50-degree field of view. Camera: Topcon TRC-50DX. Central posterior field. Captured after pupil dilation. Image size 2228x1652. Retinal fundus photograph: 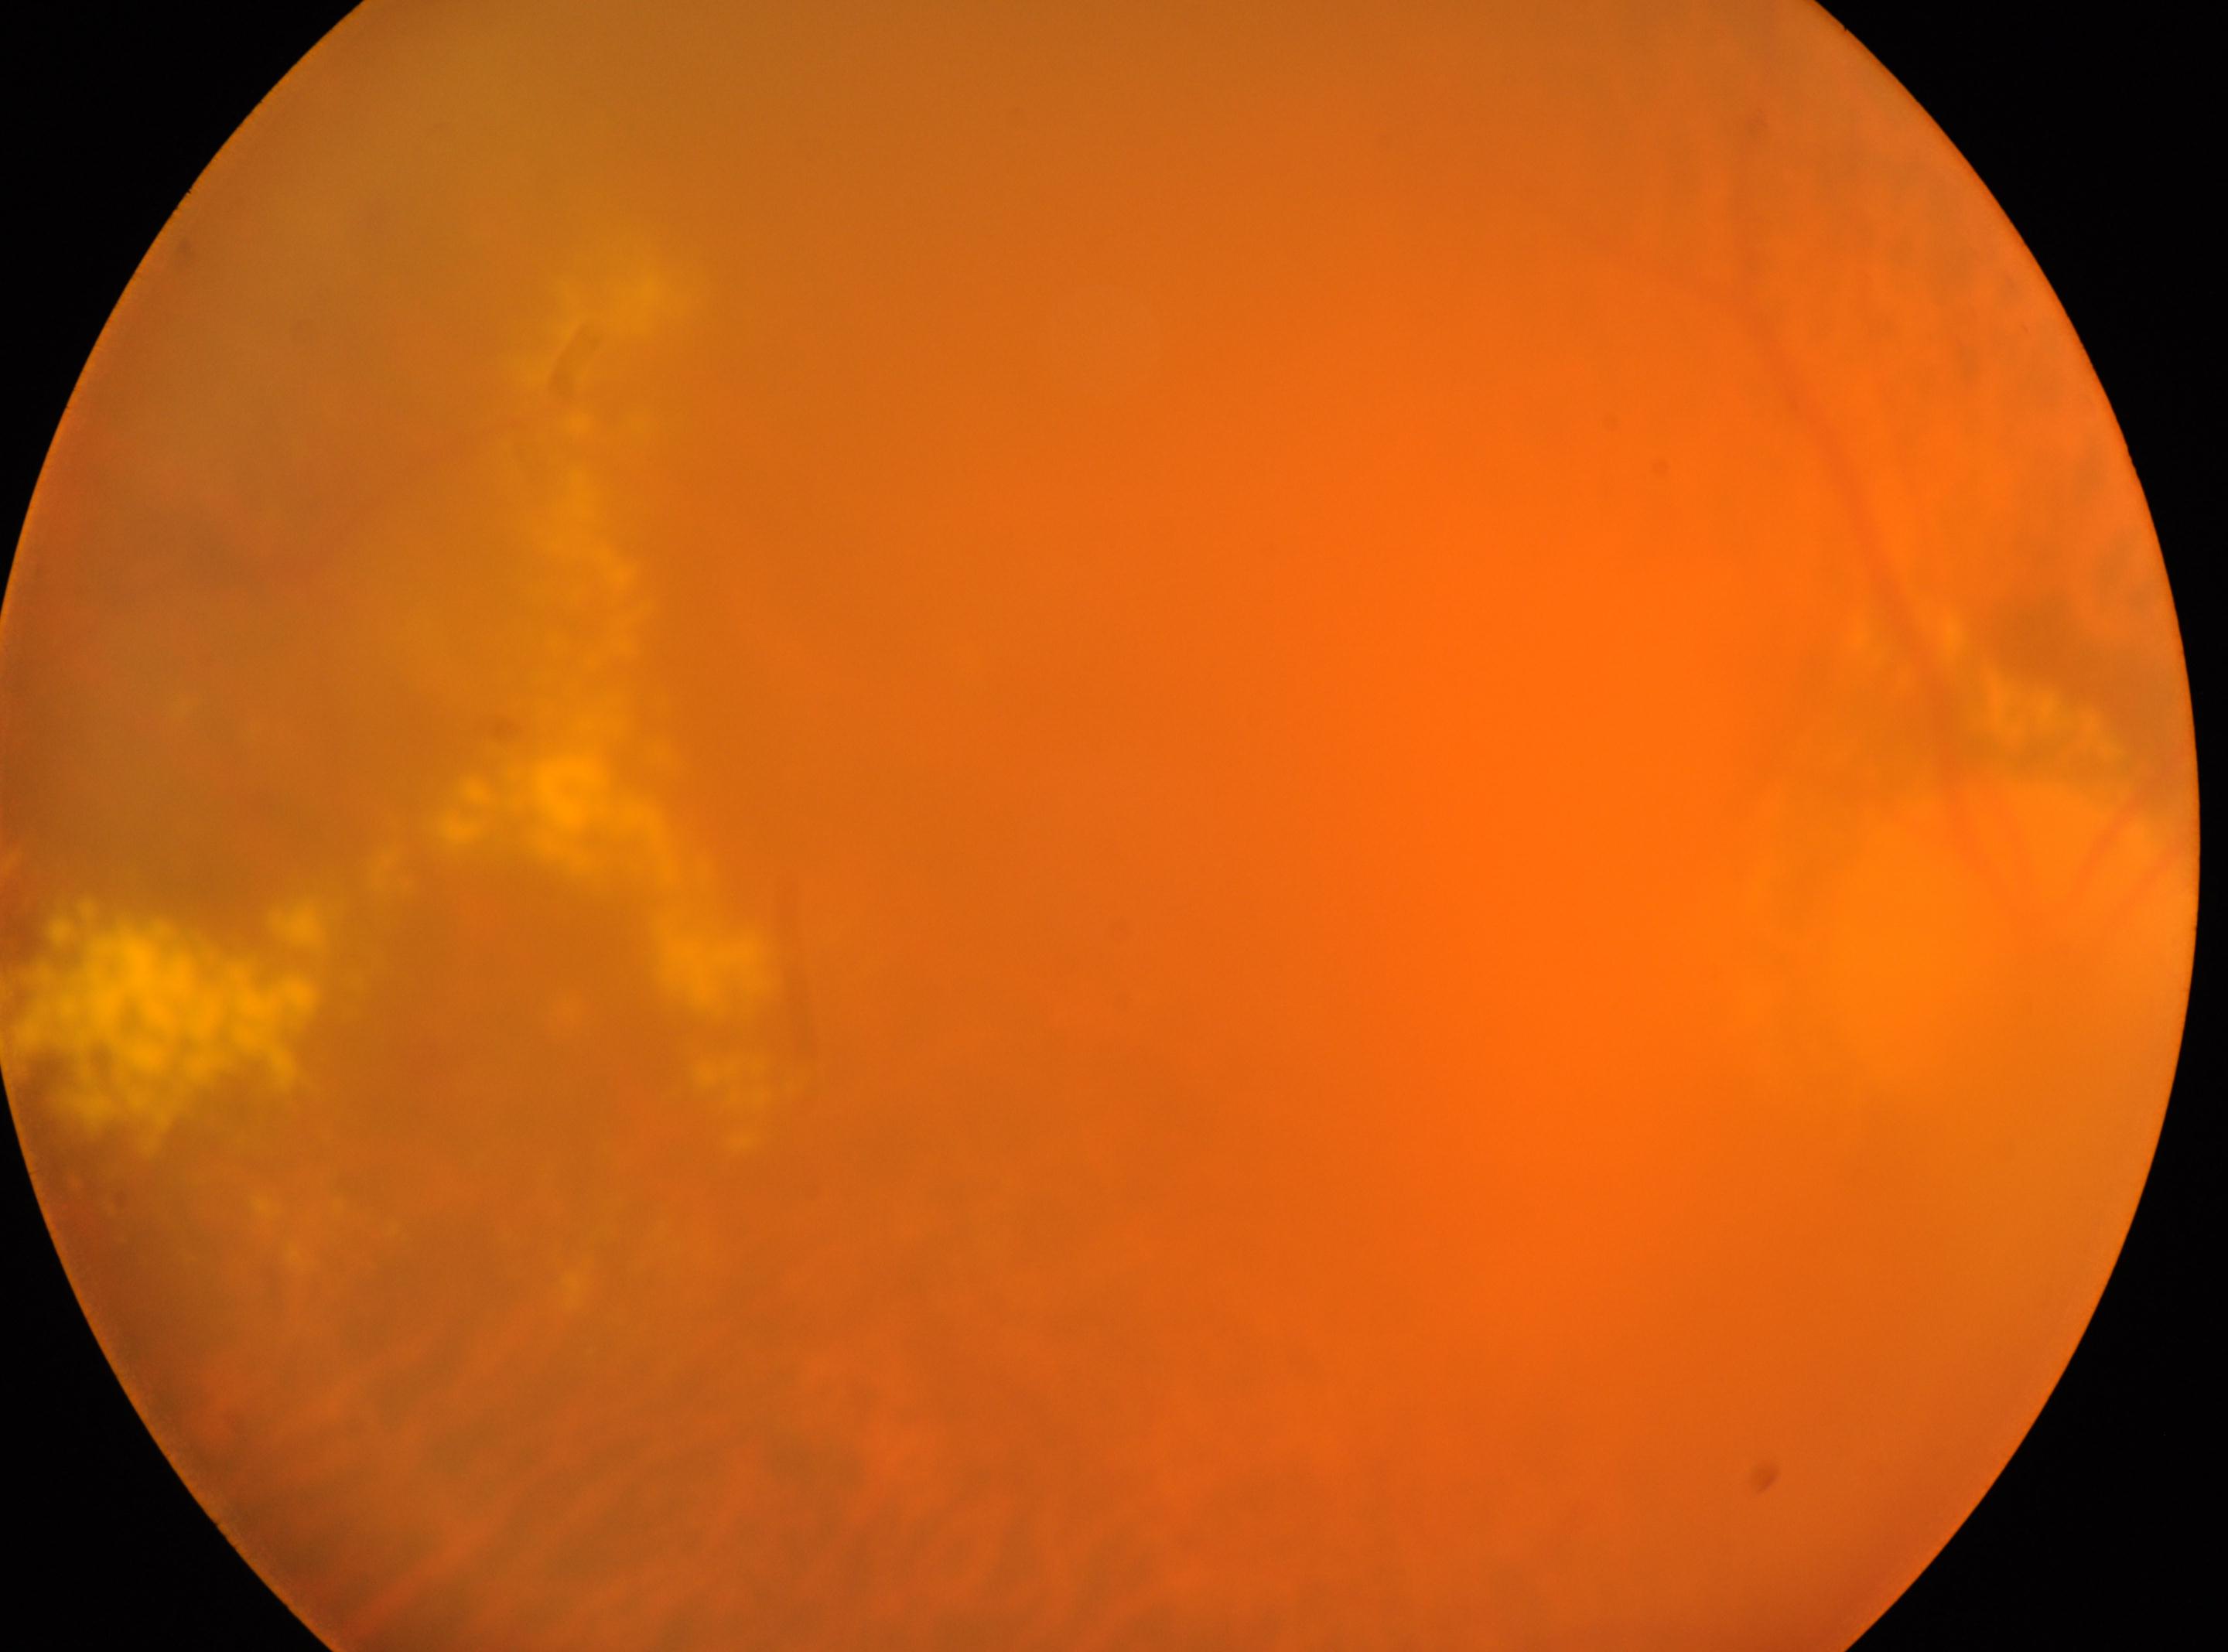 Optic disk: (x=2016, y=934).
The image shows the oculus dexter.
Fovea: (x=1191, y=1101).
DR severity: grade 2.